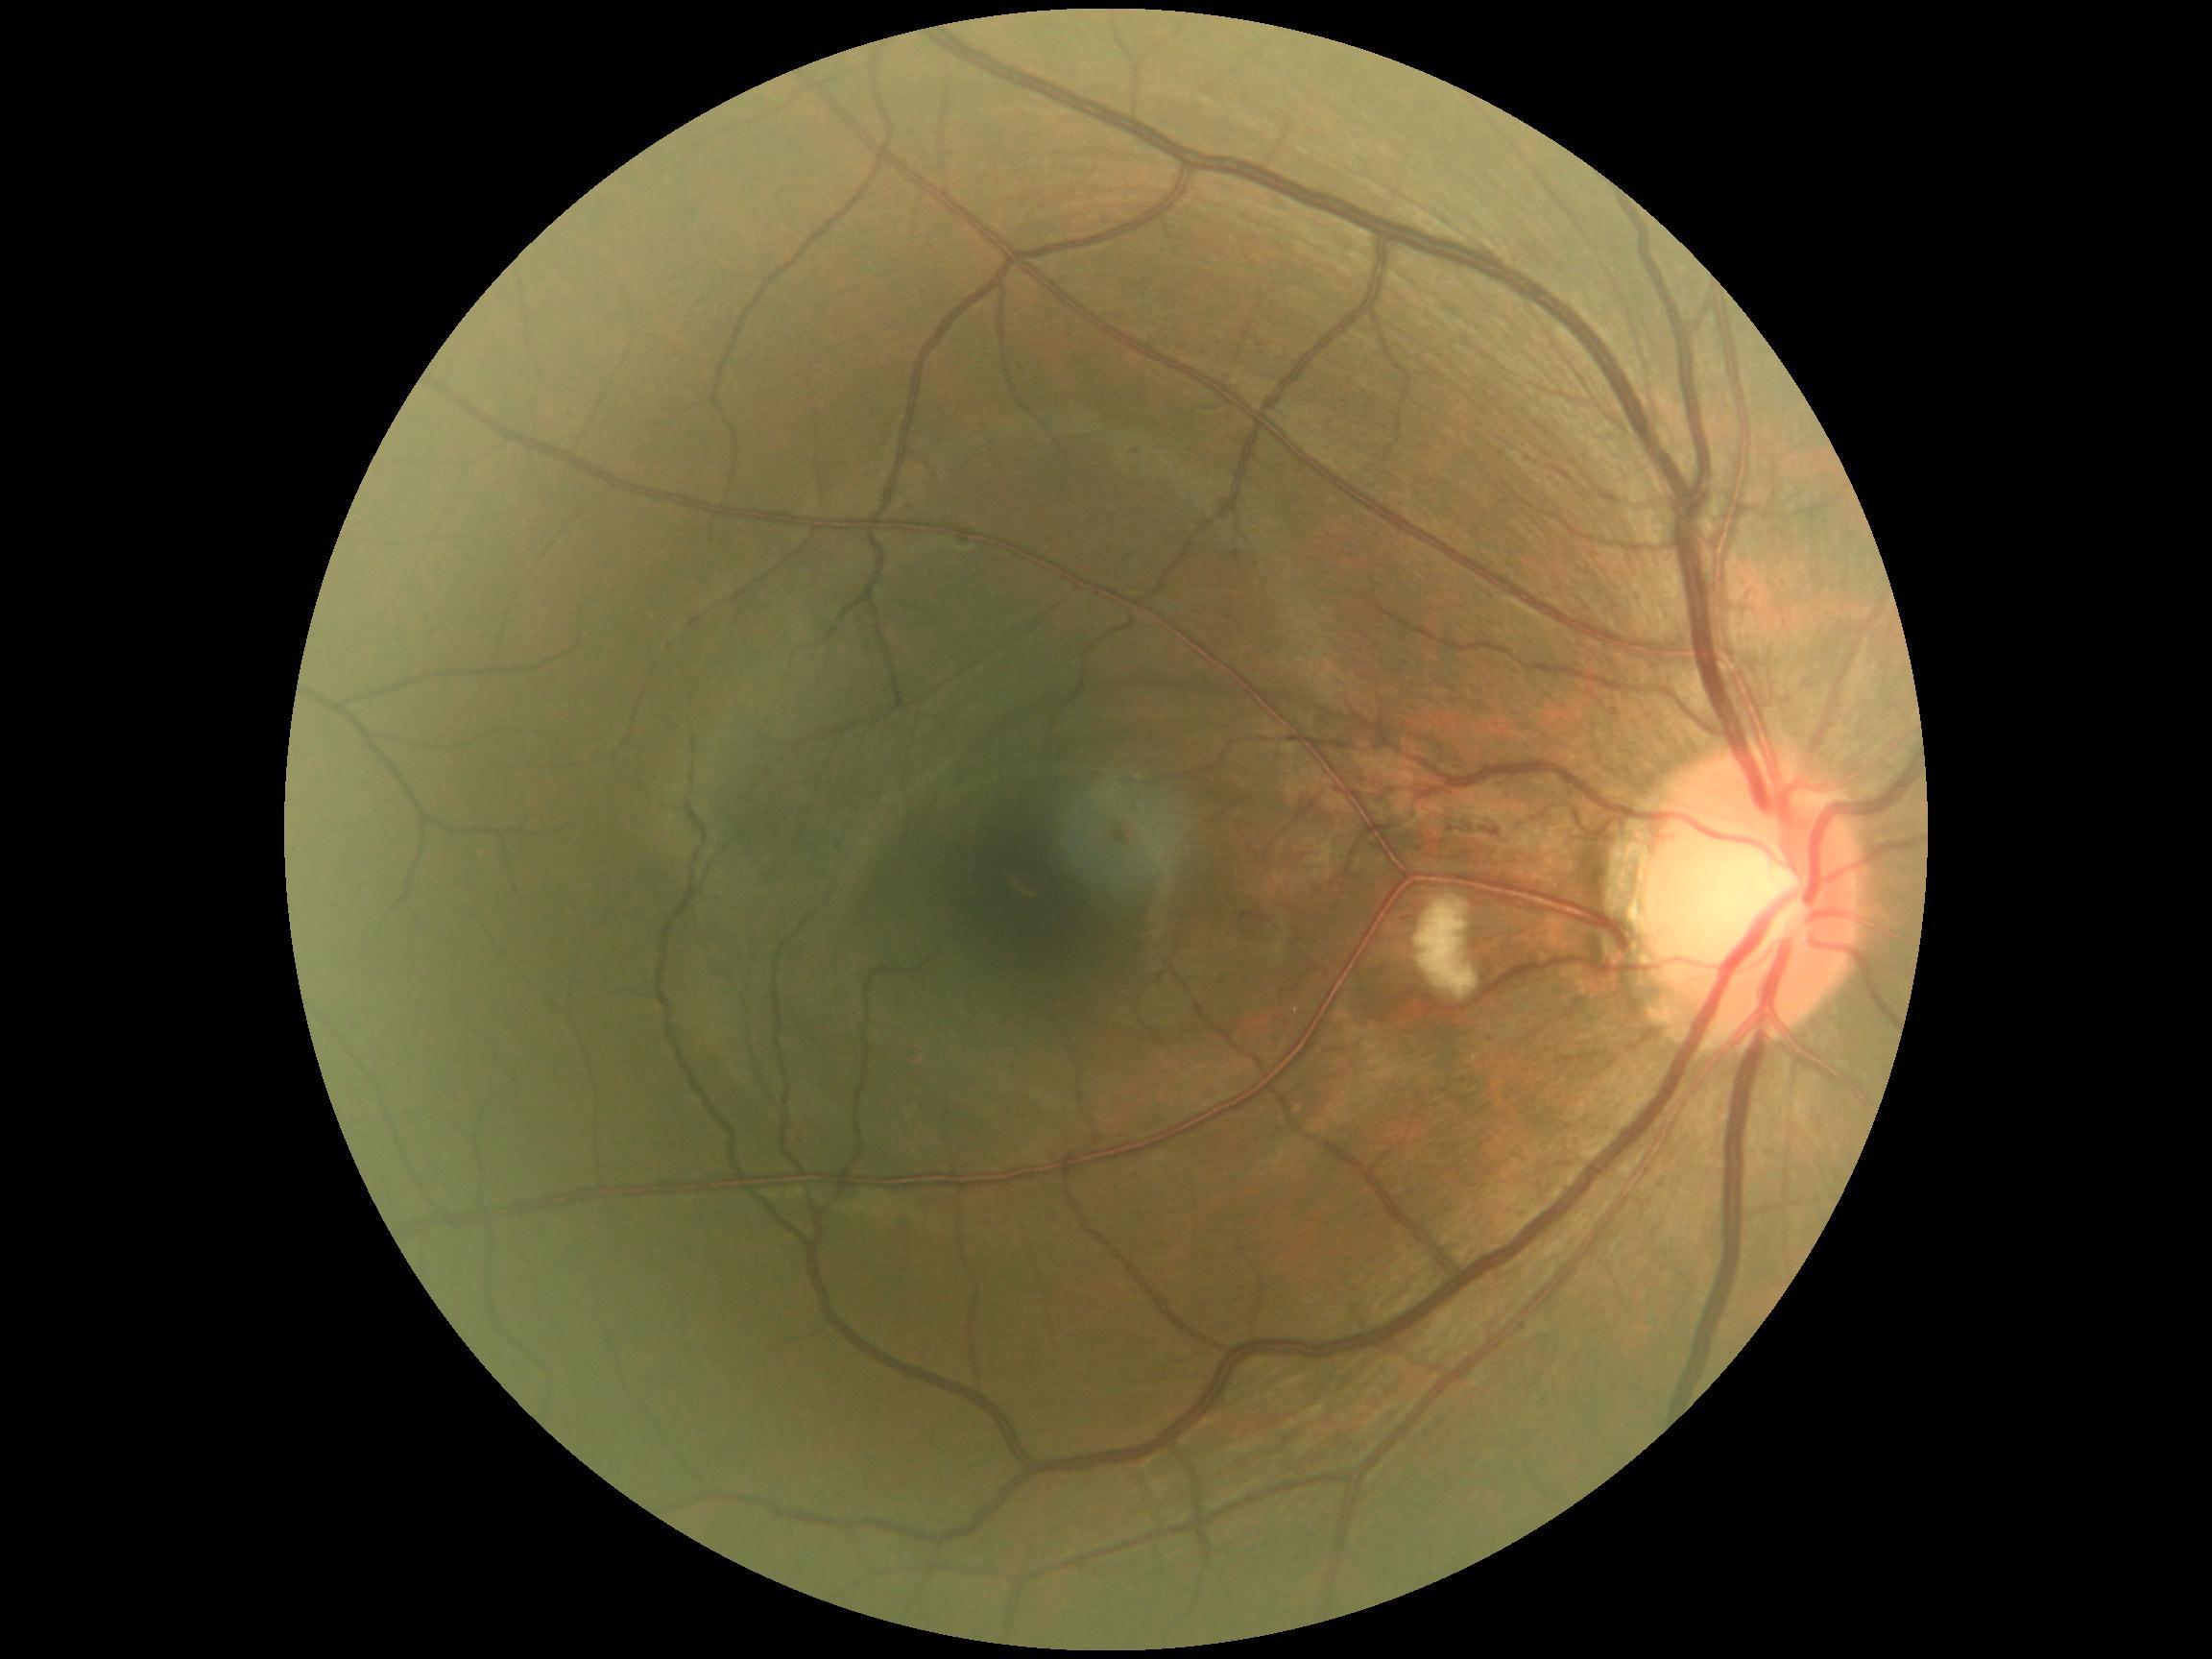

dr_grade: 2
lesions:
  he: []
  ma:
    - 1135:447:1144:457
    - 1612:709:1620:718
  ma_small_approx:
    - [x=1498, y=833]
    - [x=908, y=510]
  se:
    - 1414:895:1480:1001
  ex: []